Diabetic retinopathy graded by the modified Davis classification; 848x848; CFP; without pupil dilation — 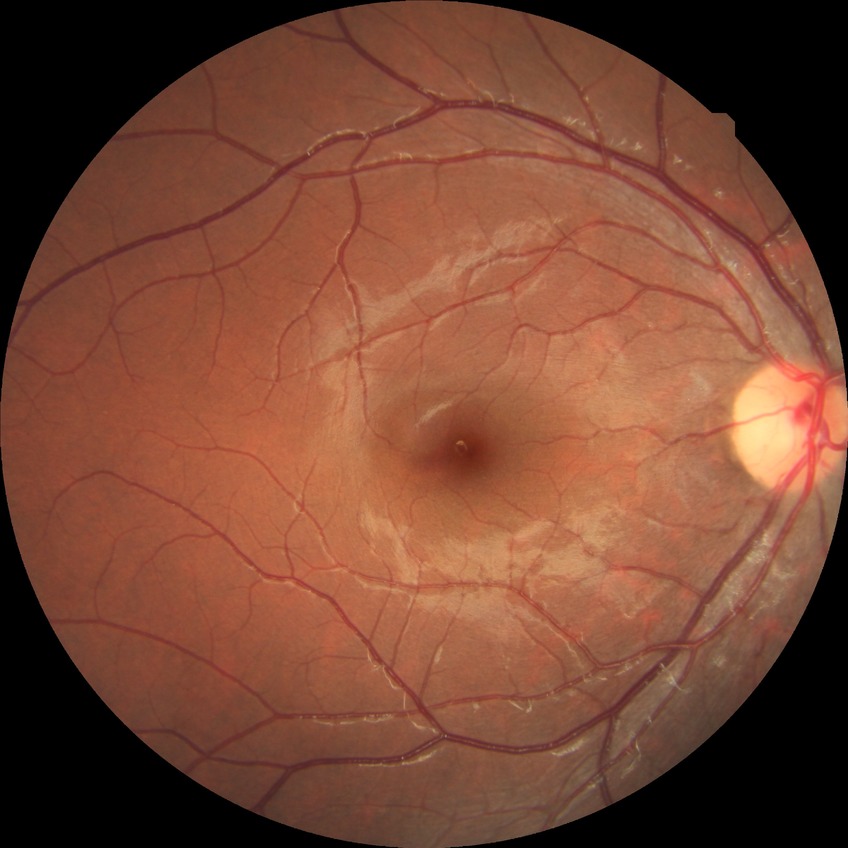
Diabetic retinopathy stage: no diabetic retinopathy.